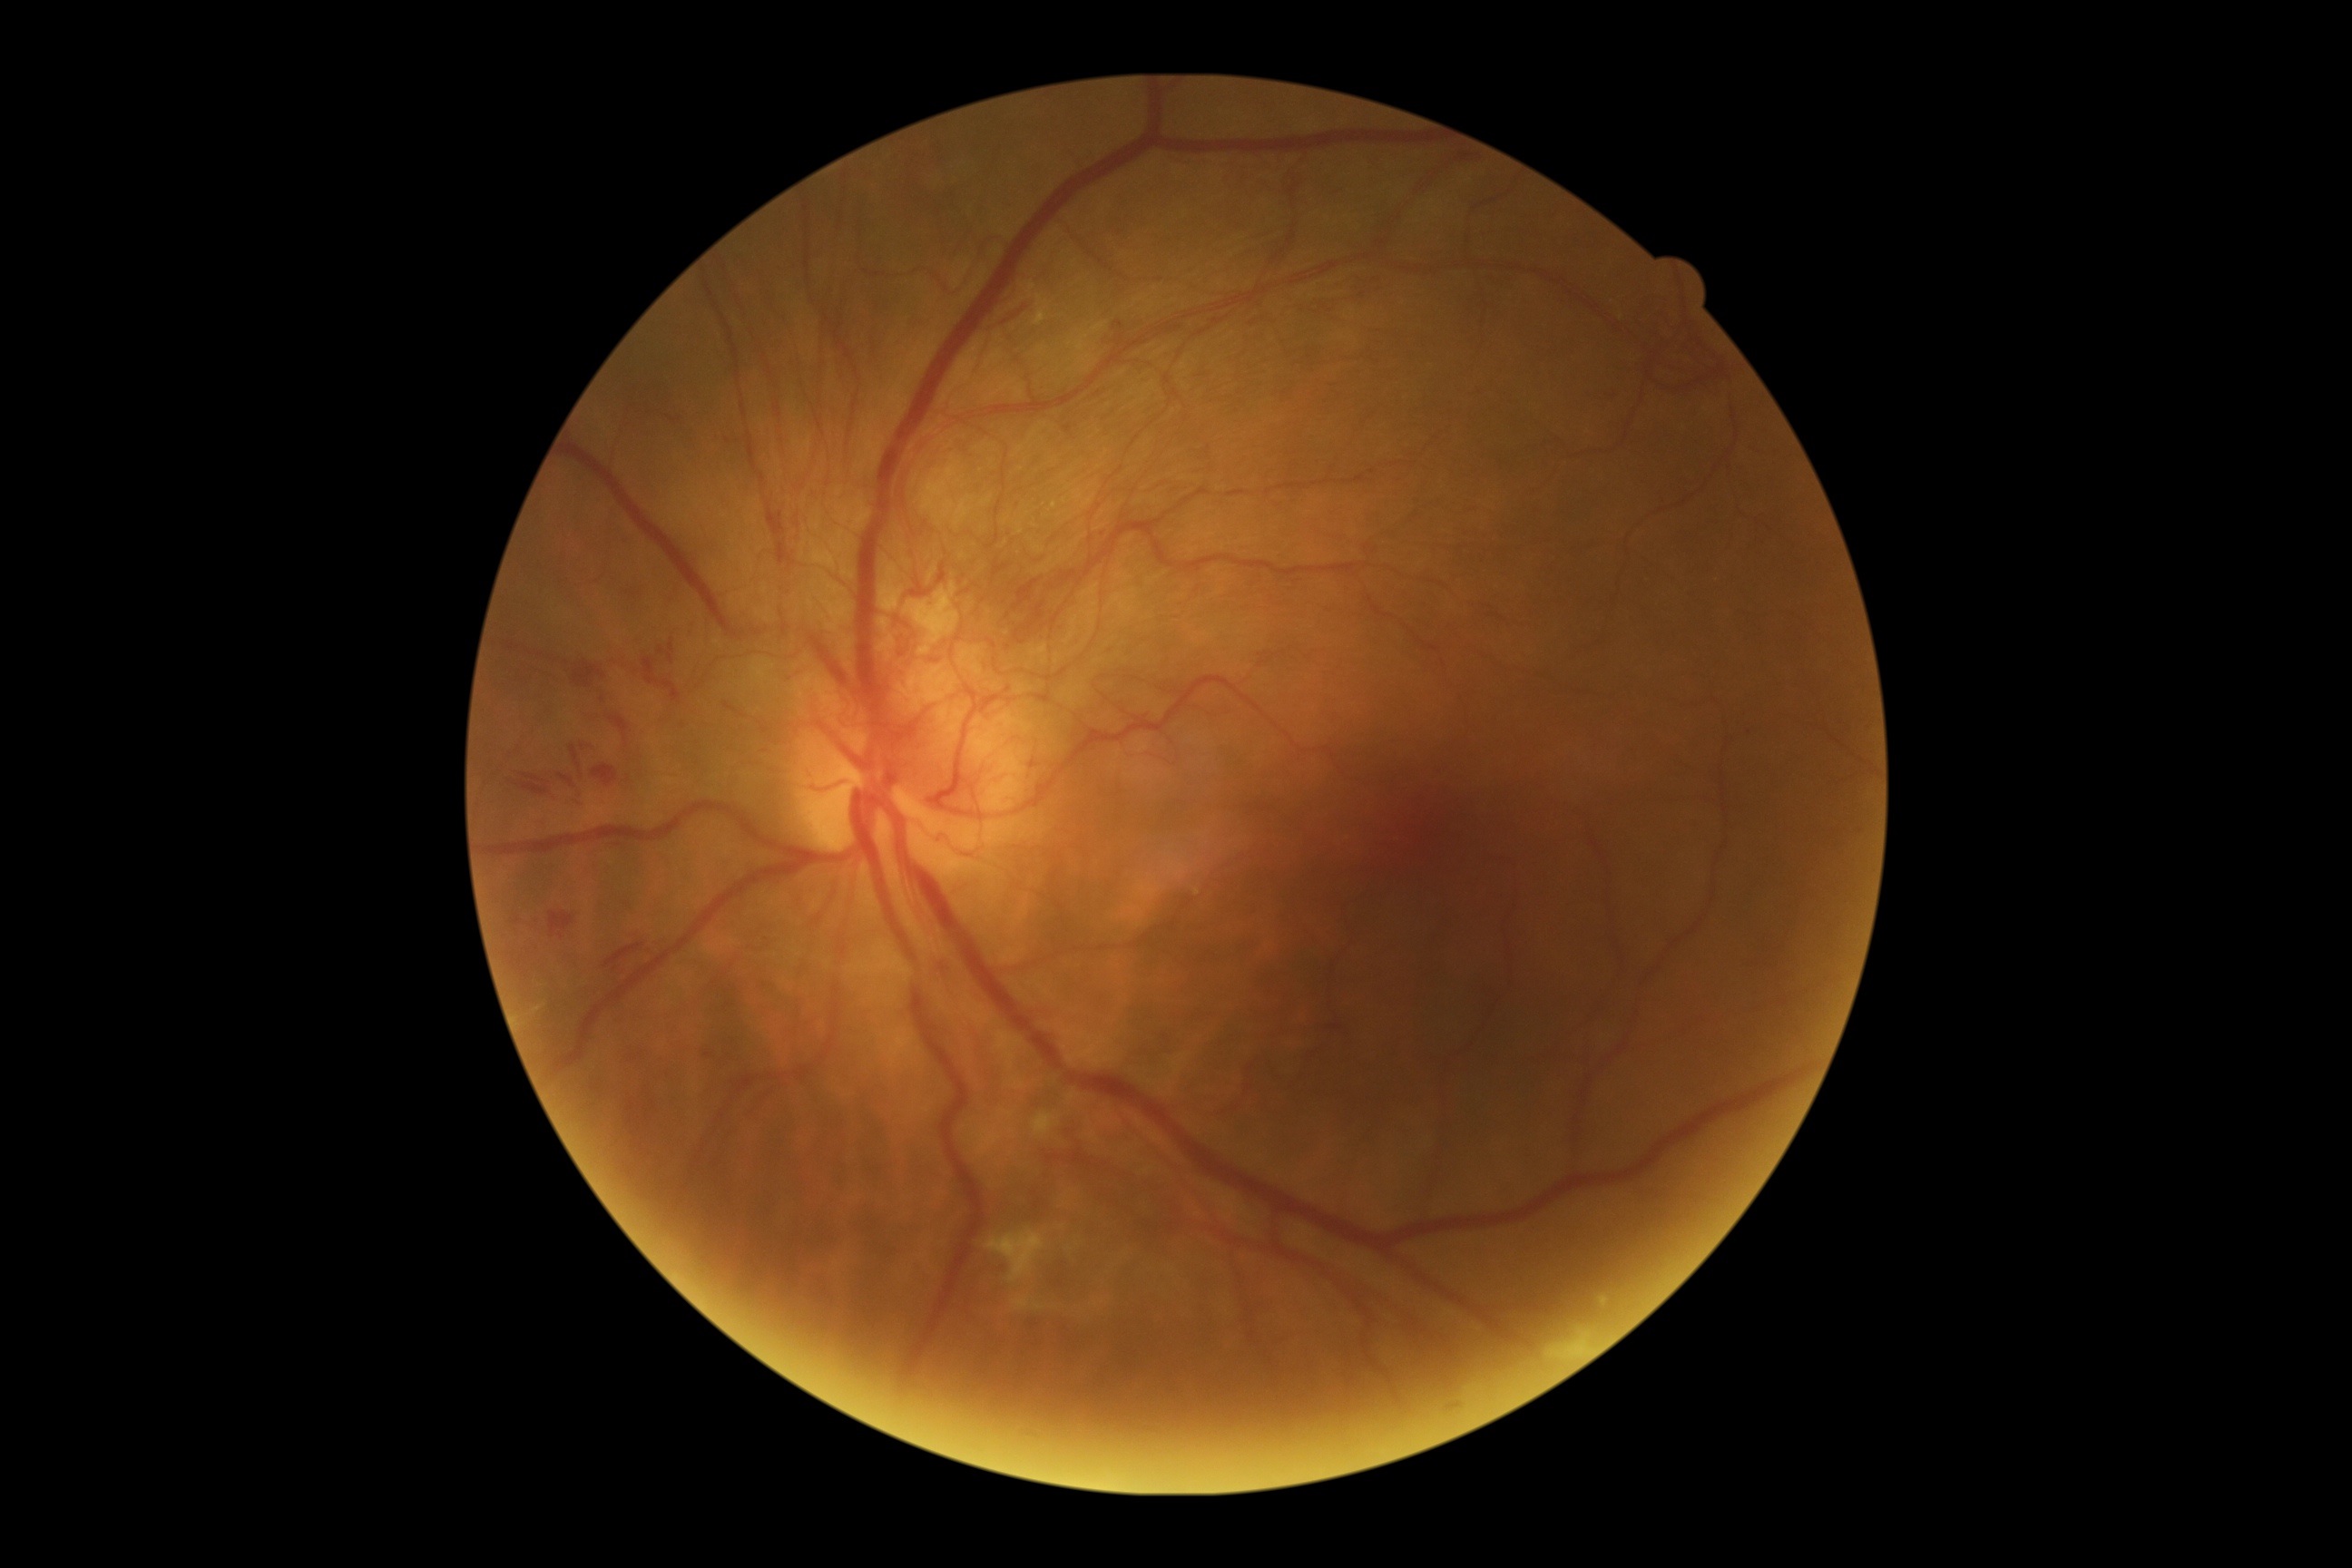
Diabetic retinopathy severity: 4/4.